Color fundus image; 45° field of view; 2352x1568px — 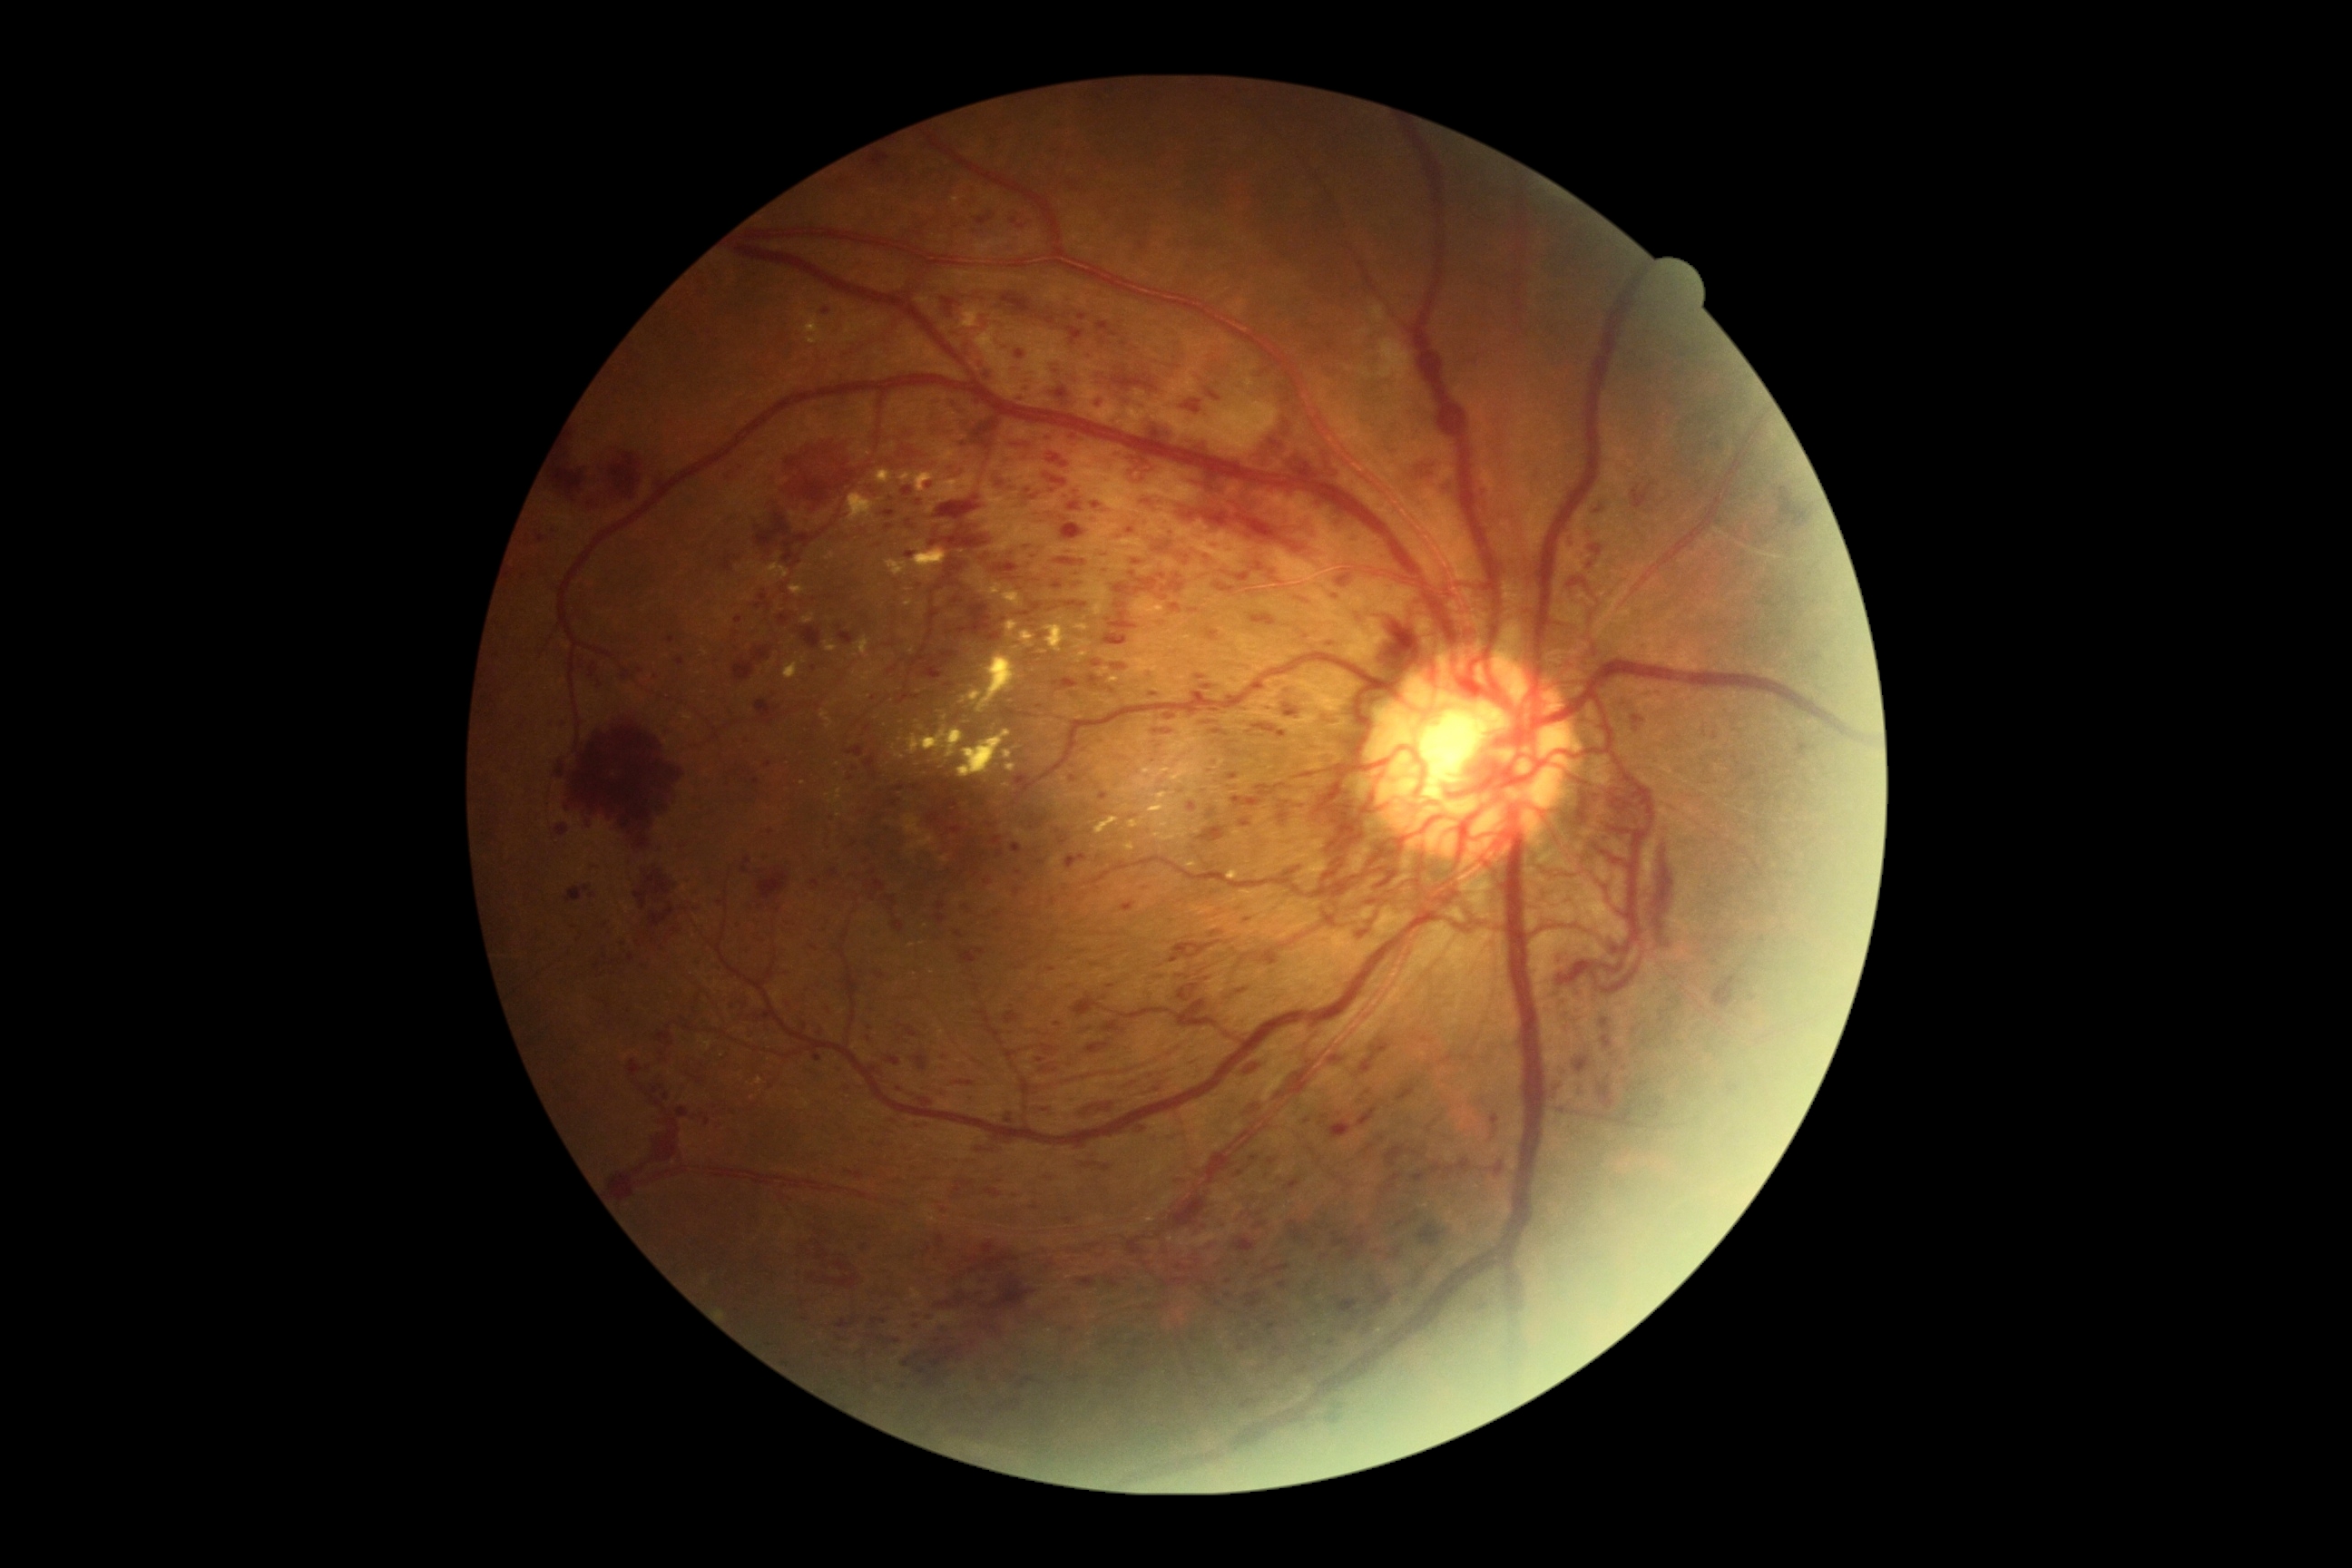
Diabetic retinopathy (DR): grade 4 (PDR). Hemorrhages (HEs) include those at 1712/975/1743/1012; 1177/985/1200/1003; 556/825/569/836; 1066/480/1322/573; 651/1083/662/1104; 1415/460/1442/480; 1422/1037/1435/1043; 1337/578/1357/593; 872/1318/887/1326; 1277/710/1298/720; 865/155/888/170; 990/1398/1023/1420; 957/603/1003/643; 1112/665/1128/671; 1331/1055/1348/1066. Additional small HEs near 880:1073; 1240:1174; 1196:697; 814:1242. Soft exudates (SEs) located at 1377/340/1411/387; 1371/306/1386/322. Hard exudates (EXs) include those at 825/642/838/652; 856/638/870/658; 908/727/965/758; 803/322/819/331; 977/620/1086/714; 1148/792/1175/828; 848/493/876/524; 961/308/981/328; 783/656/807/680; 1188/634/1191/642; 807/340/821/346; 876/471/894/484; 1095/816/1121/834; 905/600/914/607; 912/542/946/580; 1003/750/1014/760; 1128/818/1146/828. Additional small EXs near 759:1081. Microaneurysms (MAs) include those at 905/553/916/560; 905/520/916/531; 1014/888/1023/896; 881/511/896/518; 827/1008/839/1015; 745/591/769/616; 1206/683/1213/692; 885/525/894/531. Additional small MAs near 1033:559; 771:833; 868:1039; 1335:598; 963:444; 920:503; 1058:1024; 1331:645; 565:726; 1053:902.